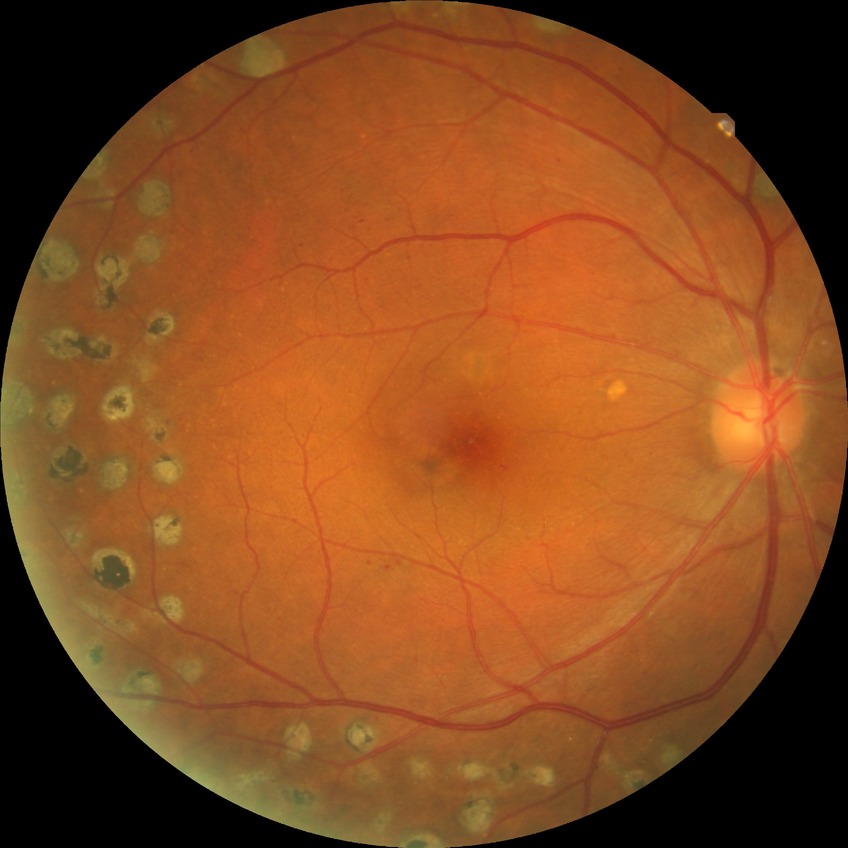 diabetic retinopathy (DR): PDR (proliferative diabetic retinopathy).